Wide-field contact fundus photograph of an infant.
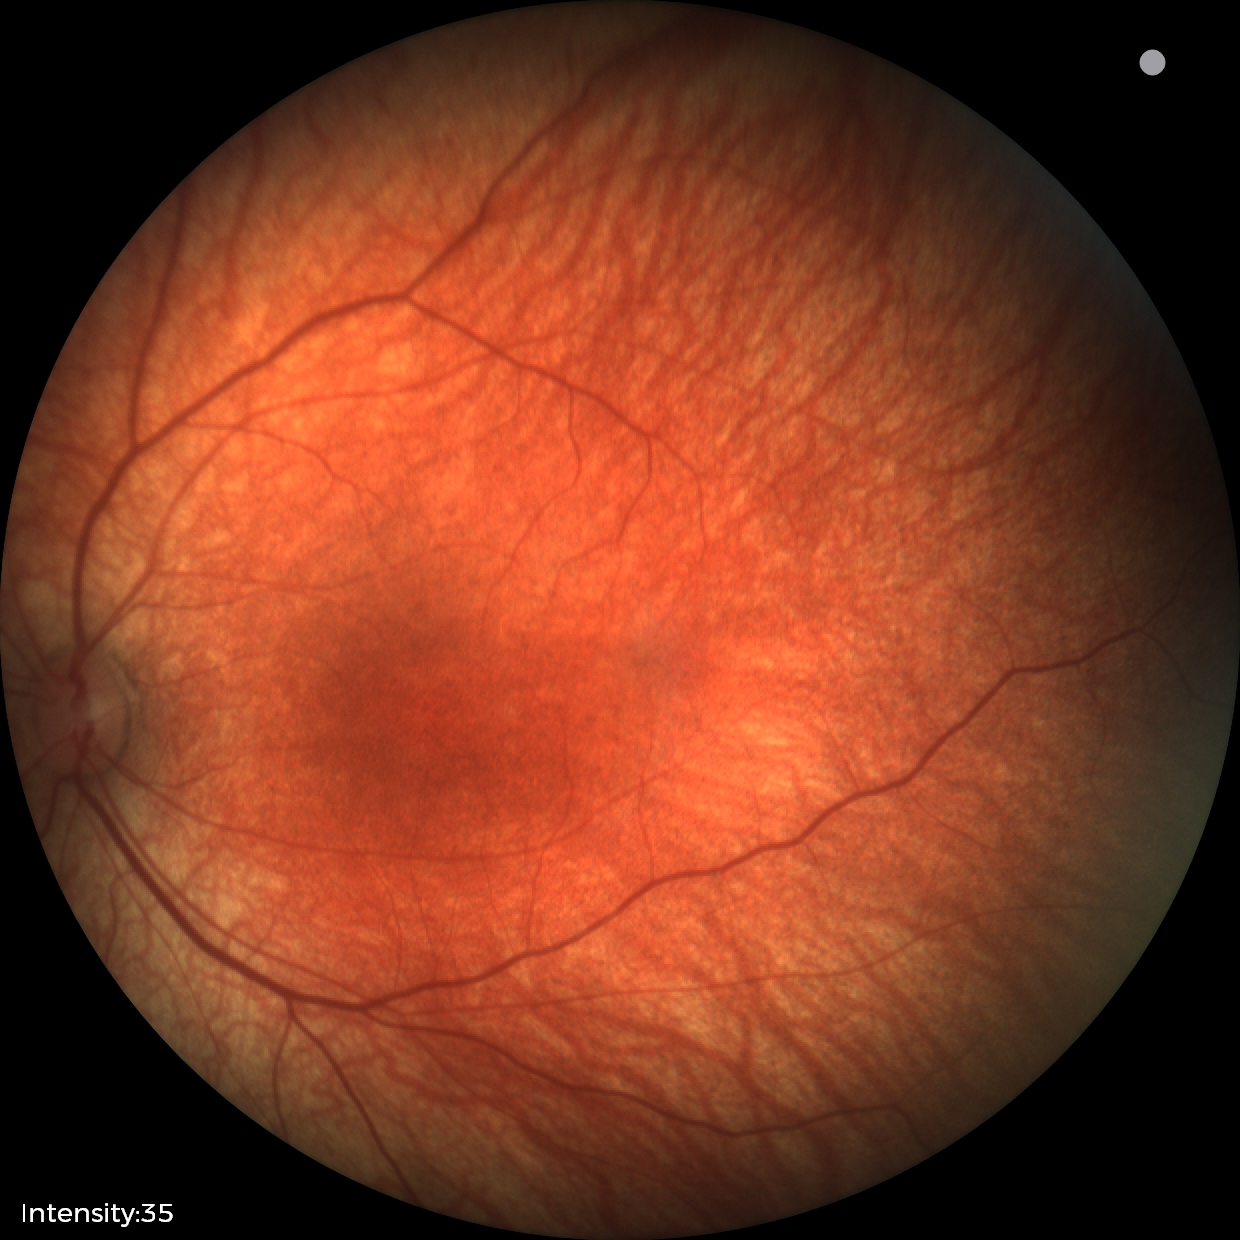 Assessment = no abnormalities